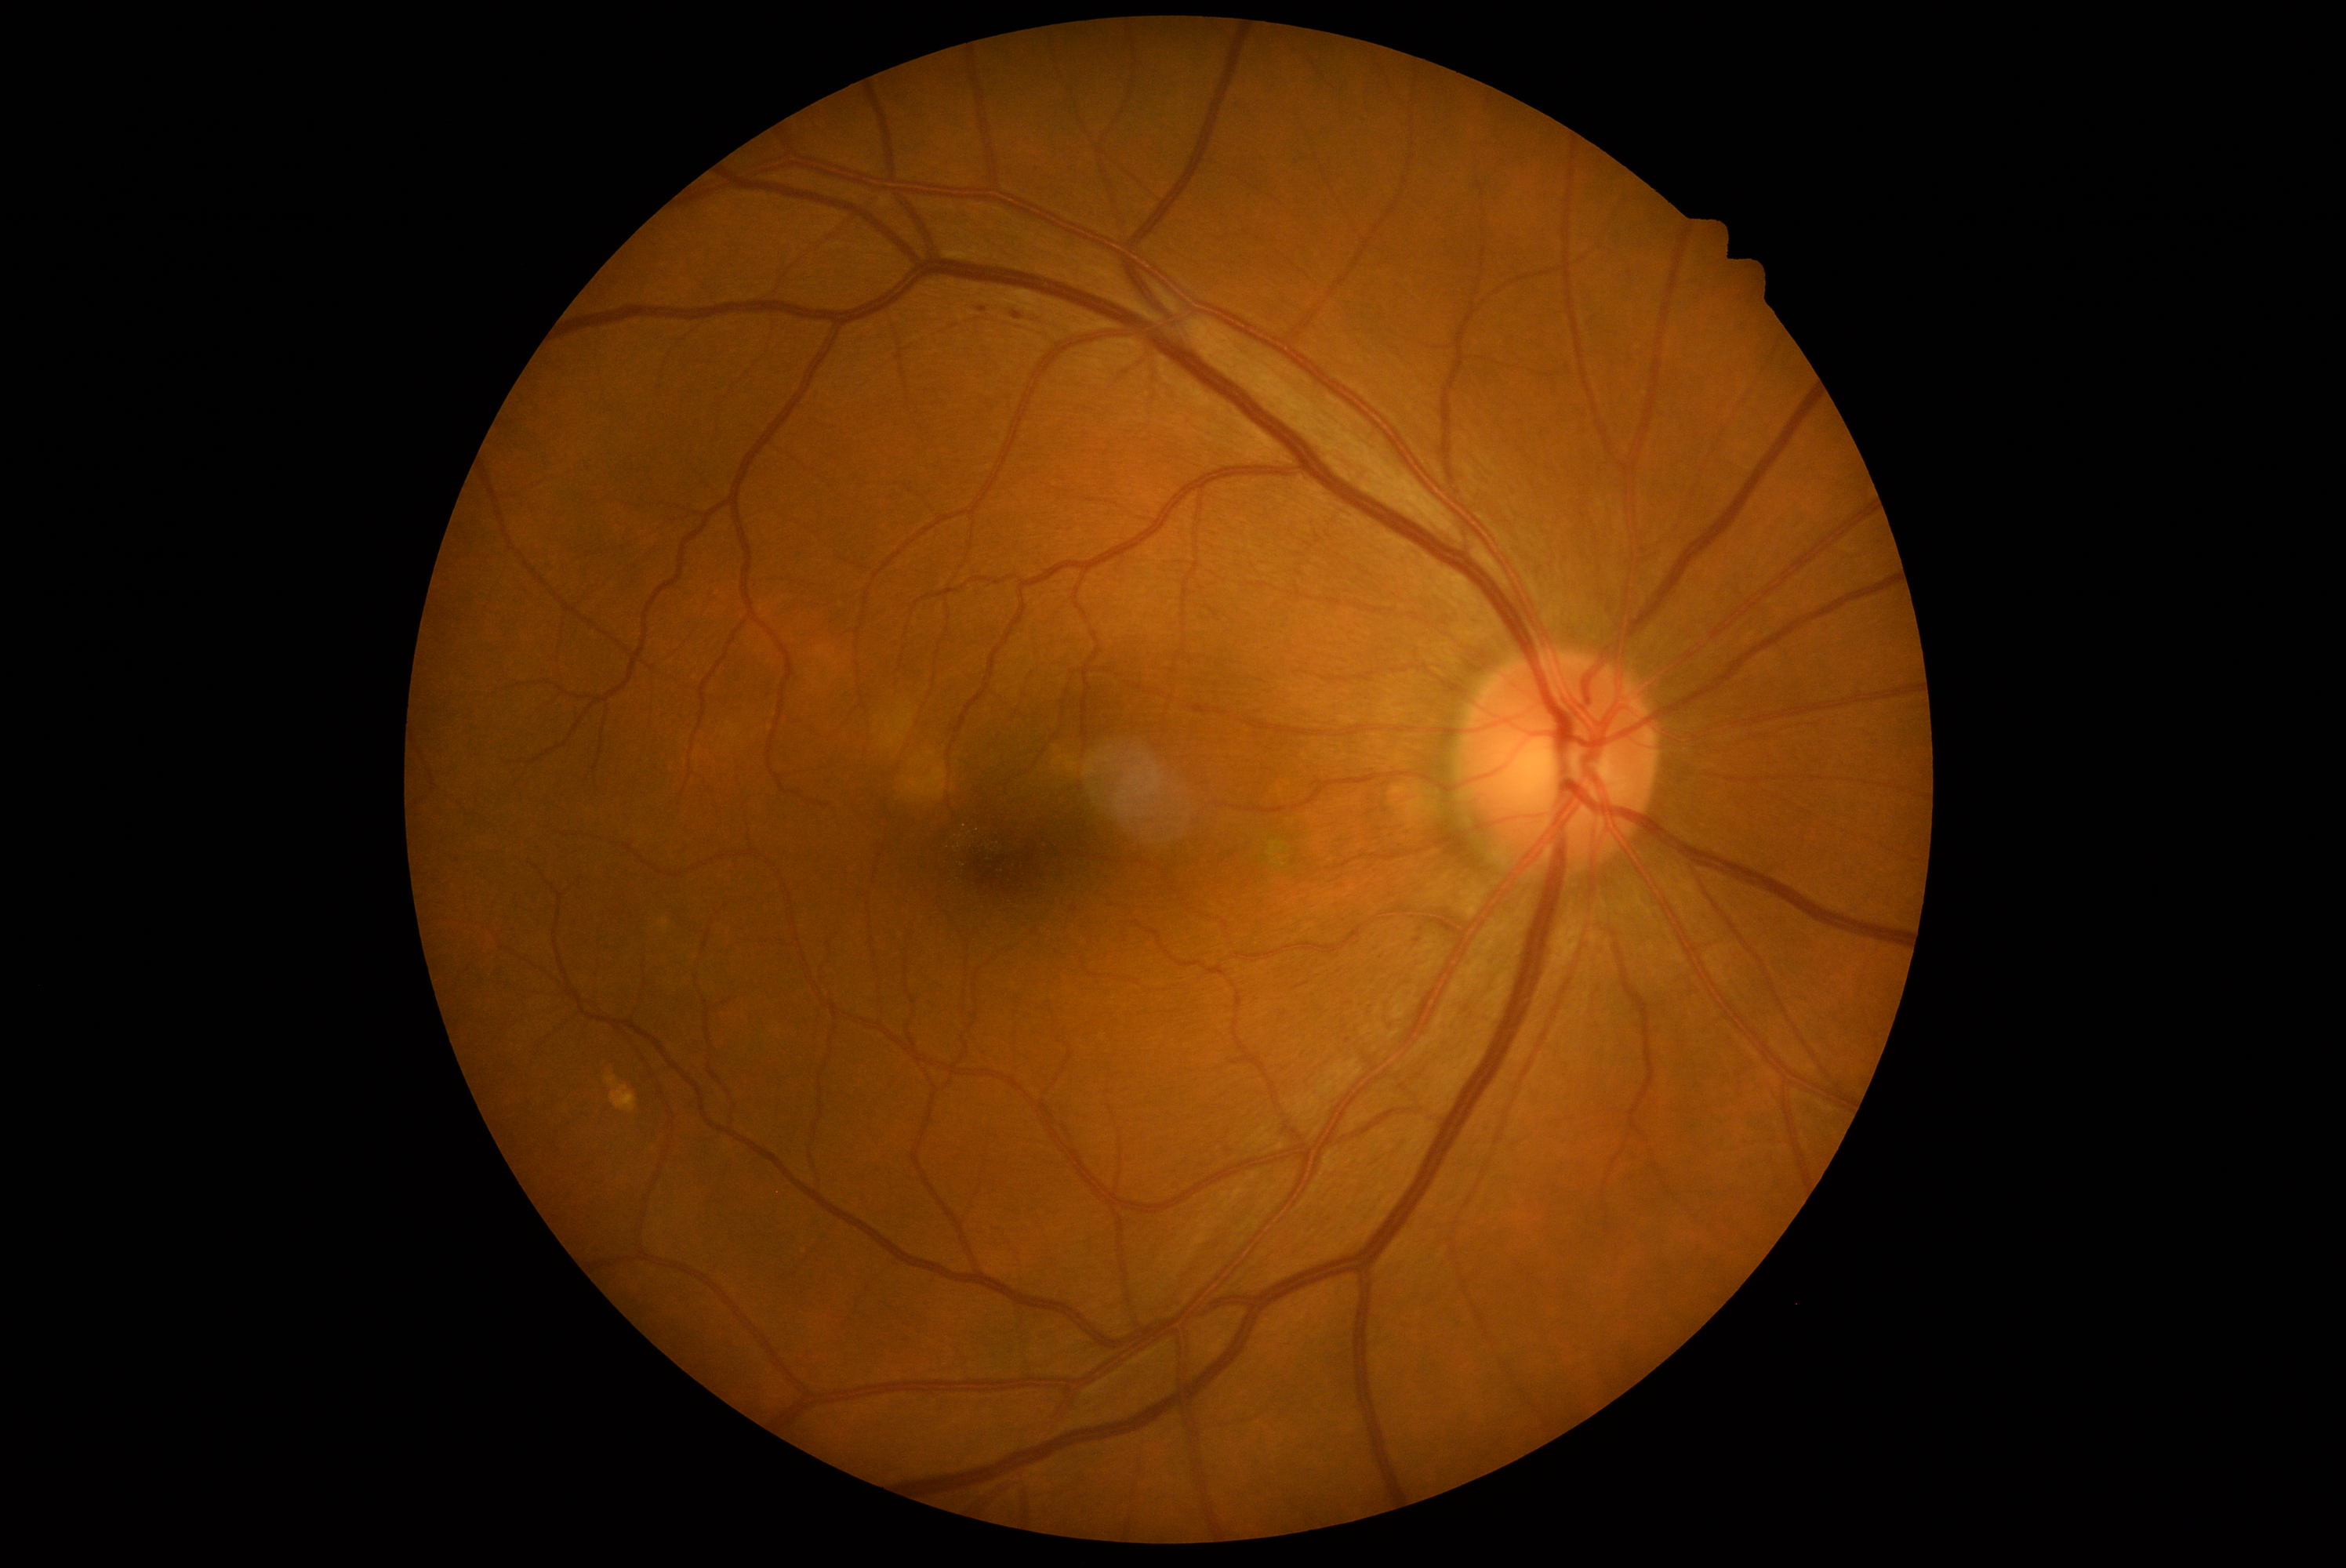

DR grade=1 (mild NPDR); DR class=non-proliferative diabetic retinopathy.